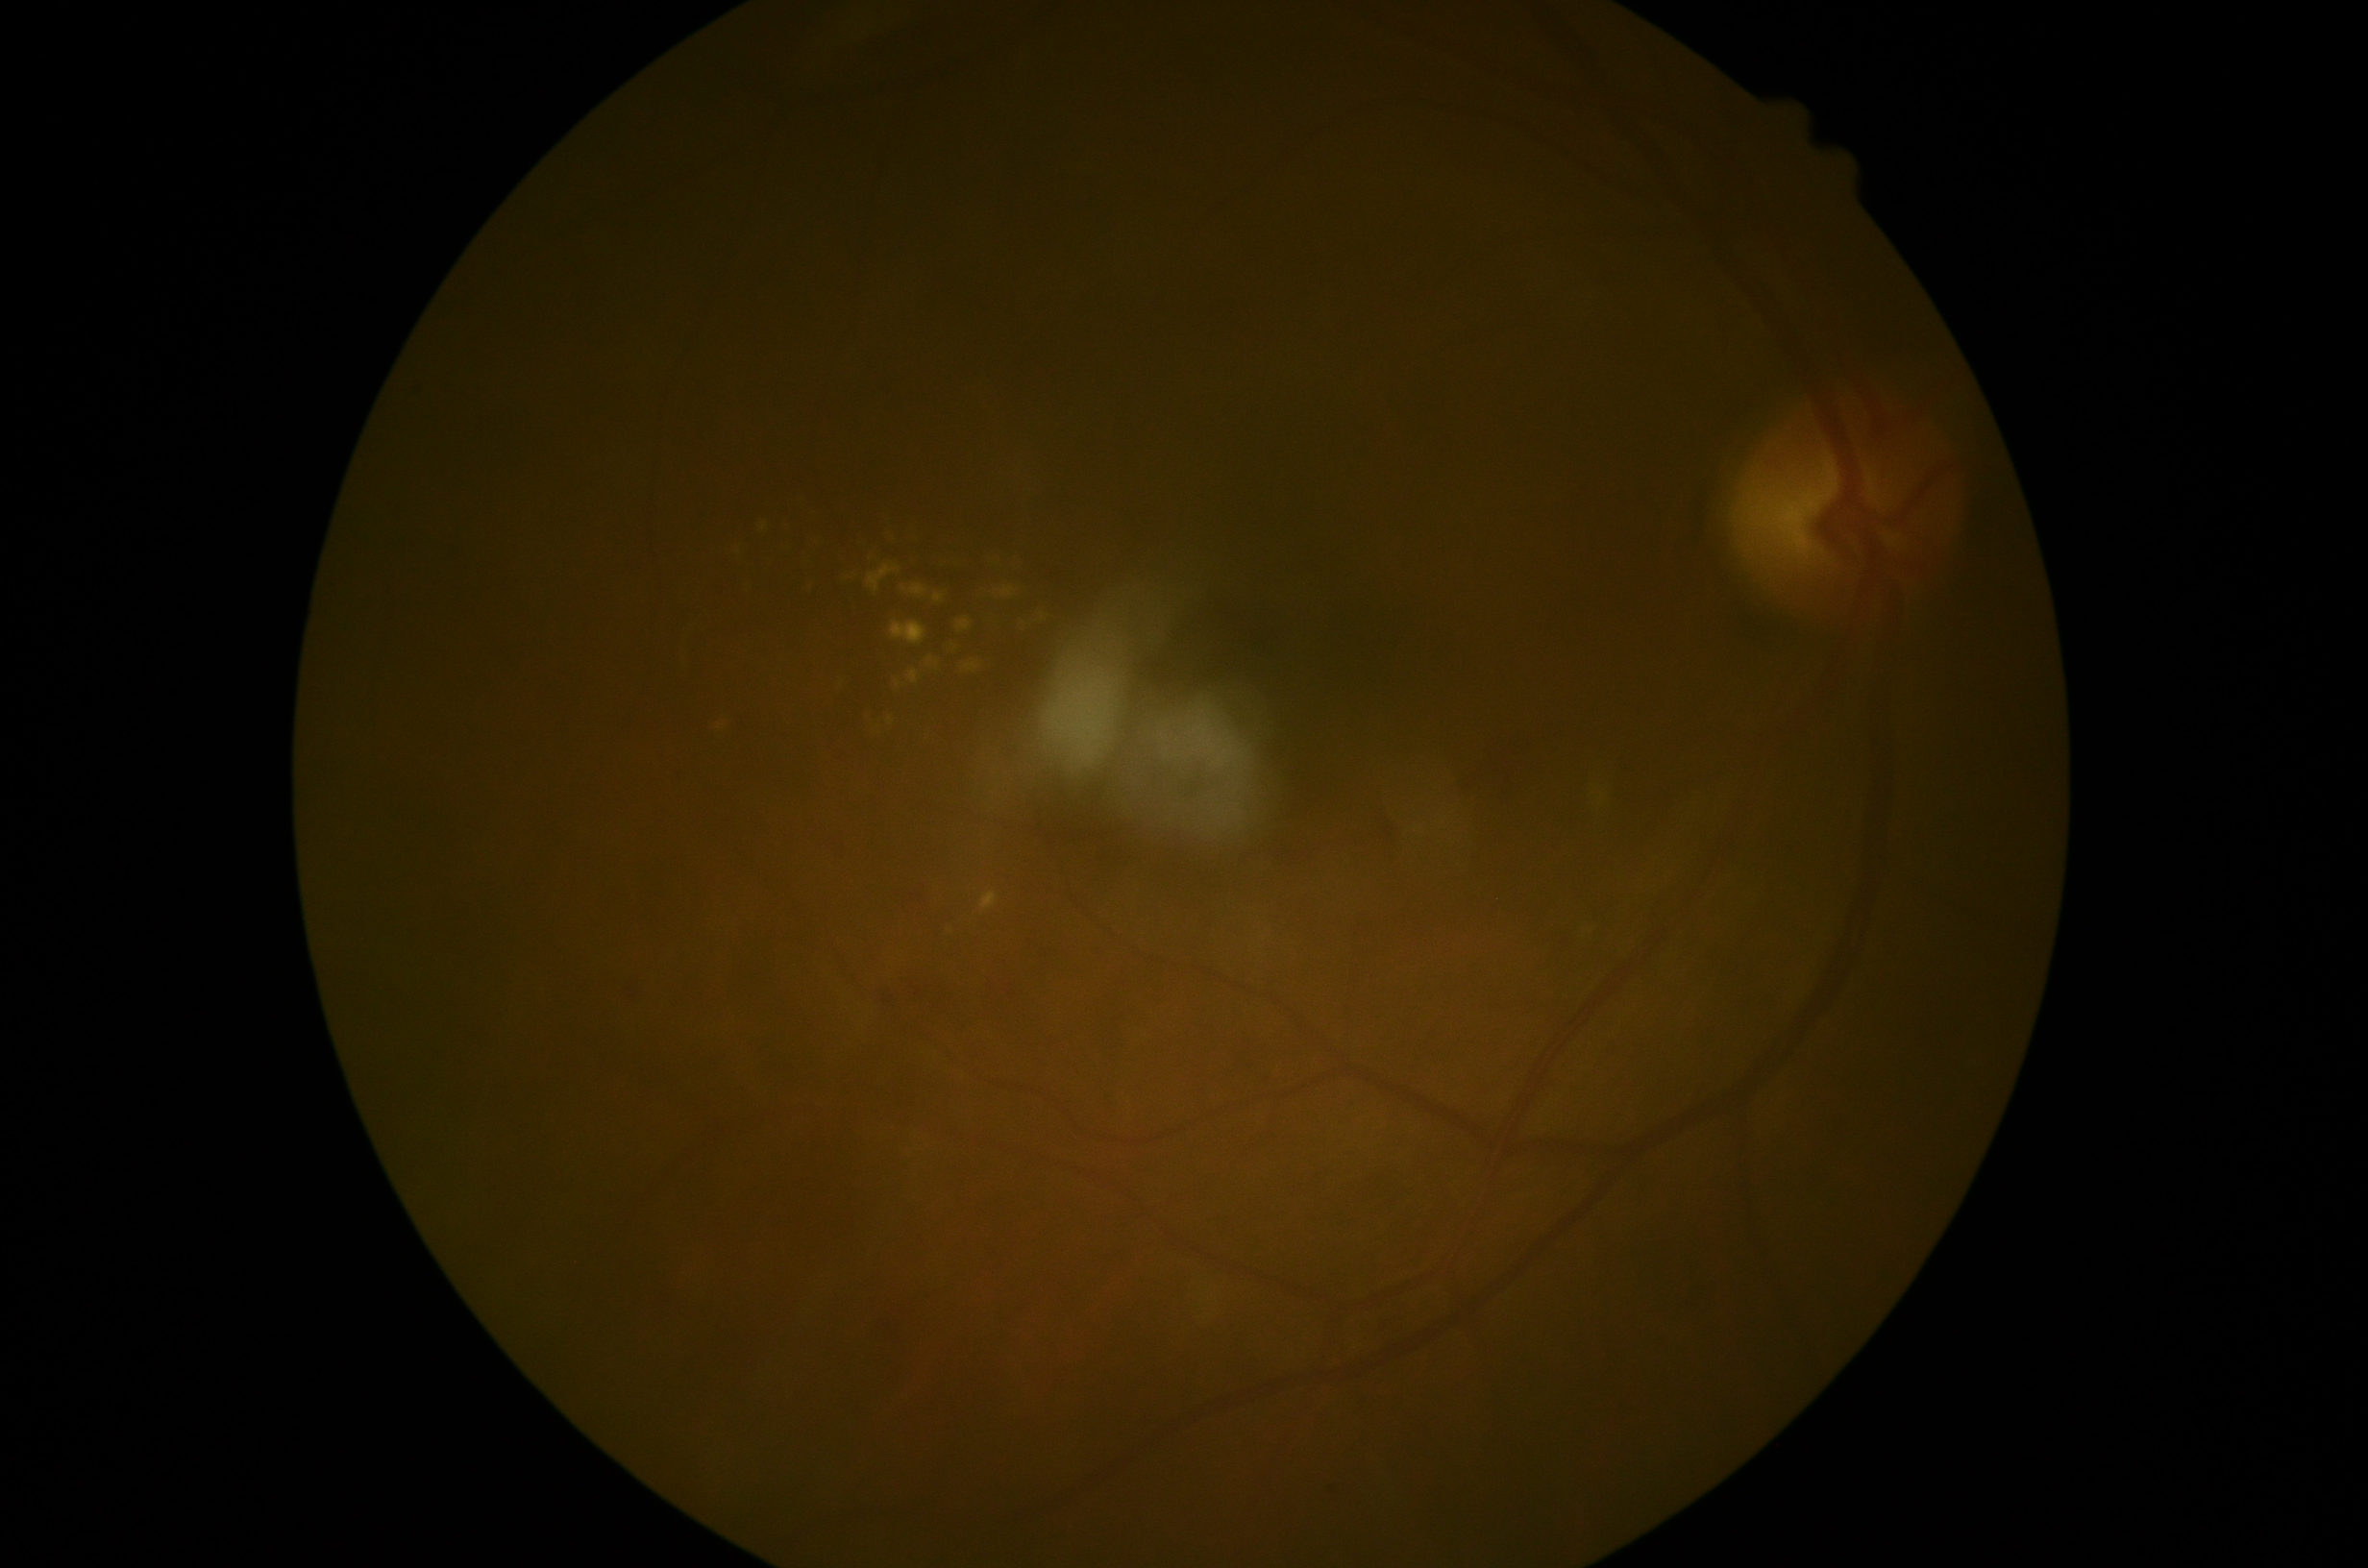

Disease class: non-proliferative diabetic retinopathy. DR: grade 2 (moderate NPDR).